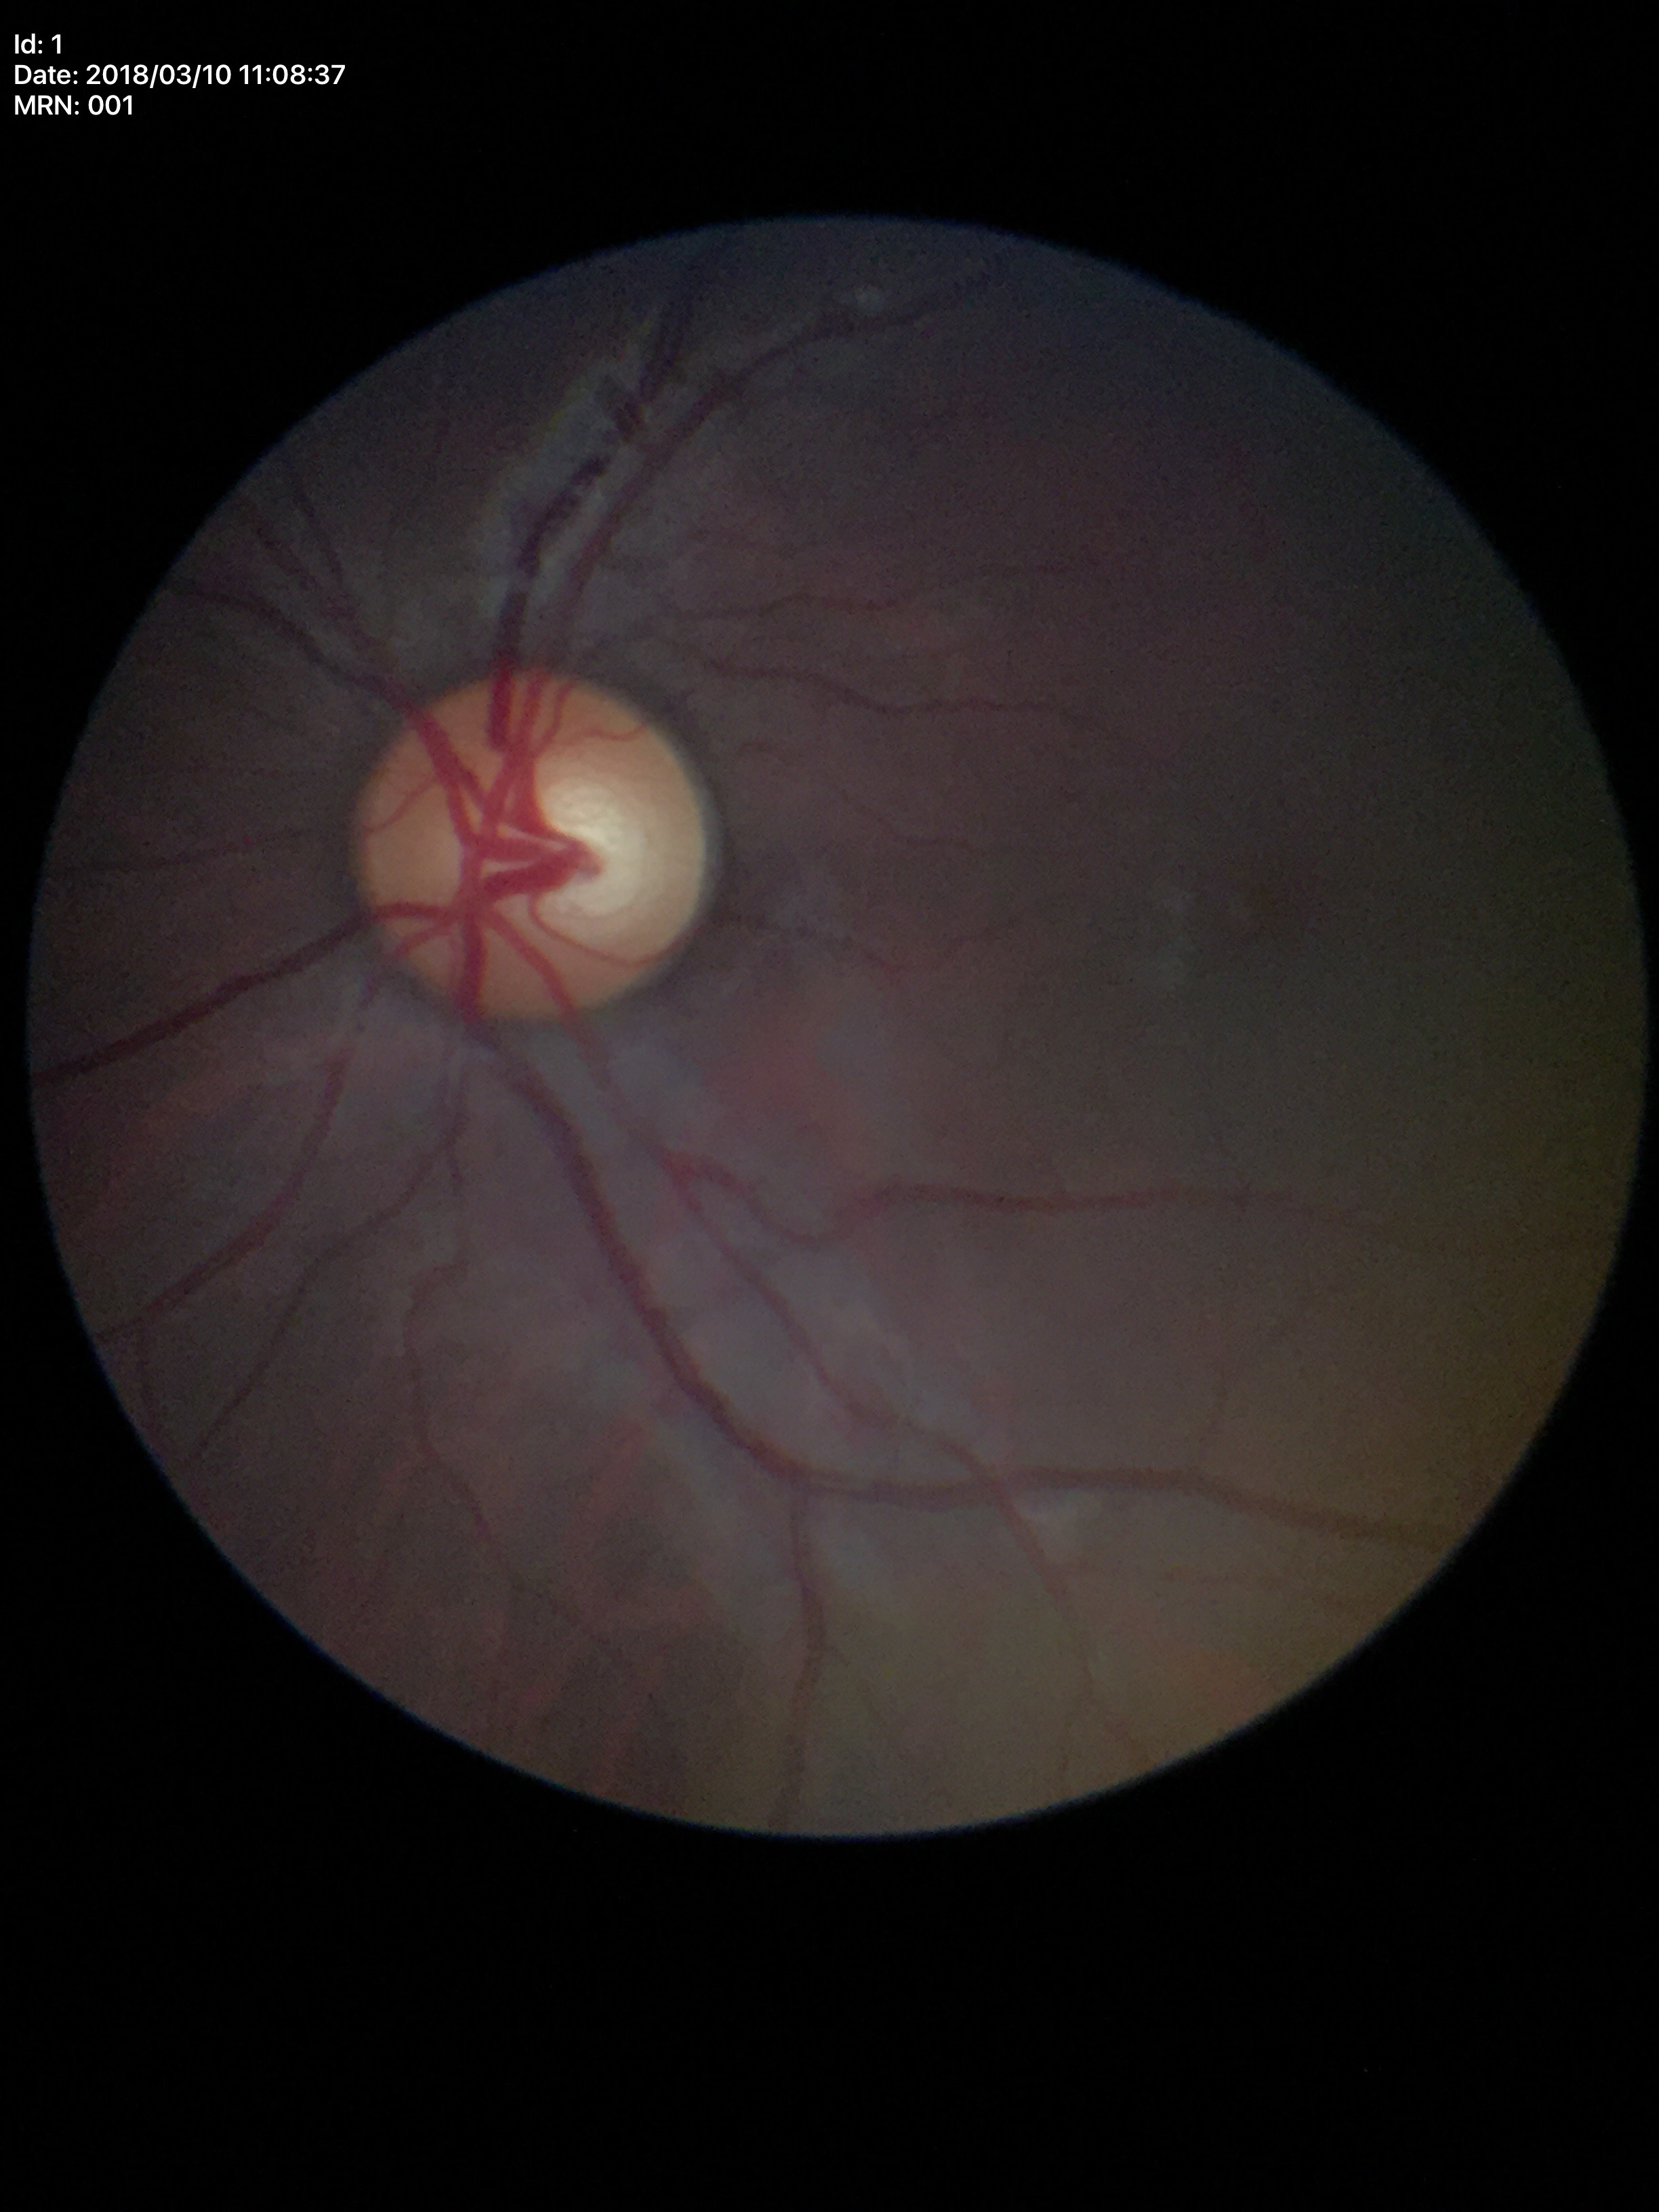
  glaucoma_decision: no suspicious findings (5/5 ophthalmologists in agreement)
  vcdr: 0.52
  hcdr: 0.55